Without pupil dilation · 45° field of view · 848x848px · posterior pole color fundus photograph
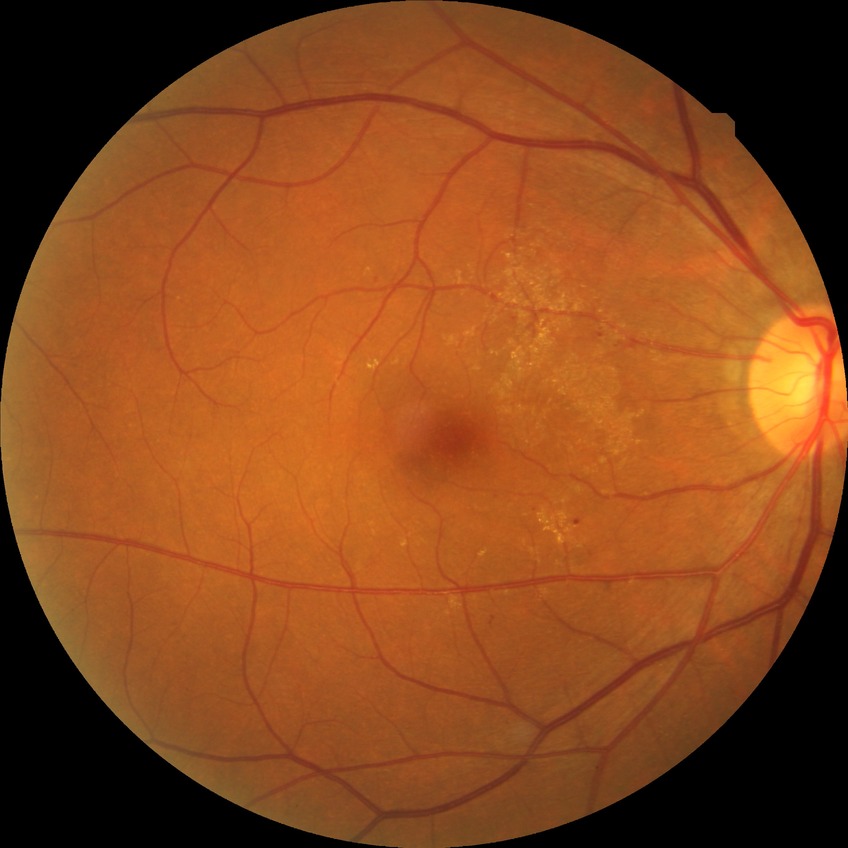
diabetic retinopathy (DR)@SDR (simple diabetic retinopathy).